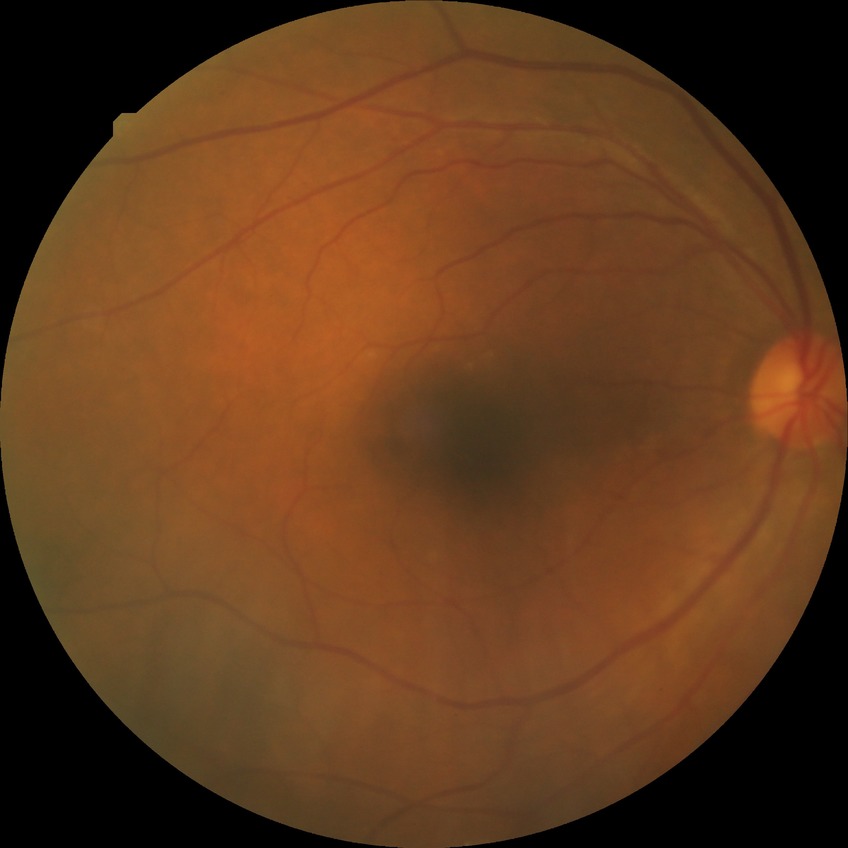 DR severity: PPDR.